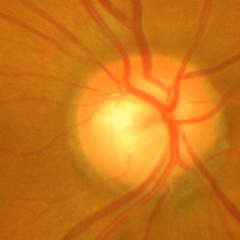 Glaucoma stage: advanced-stage glaucoma. Diagnostic criteria: near-total cupping of the optic nerve head, with or without severe visual field loss within the central 10 degrees of fixation.